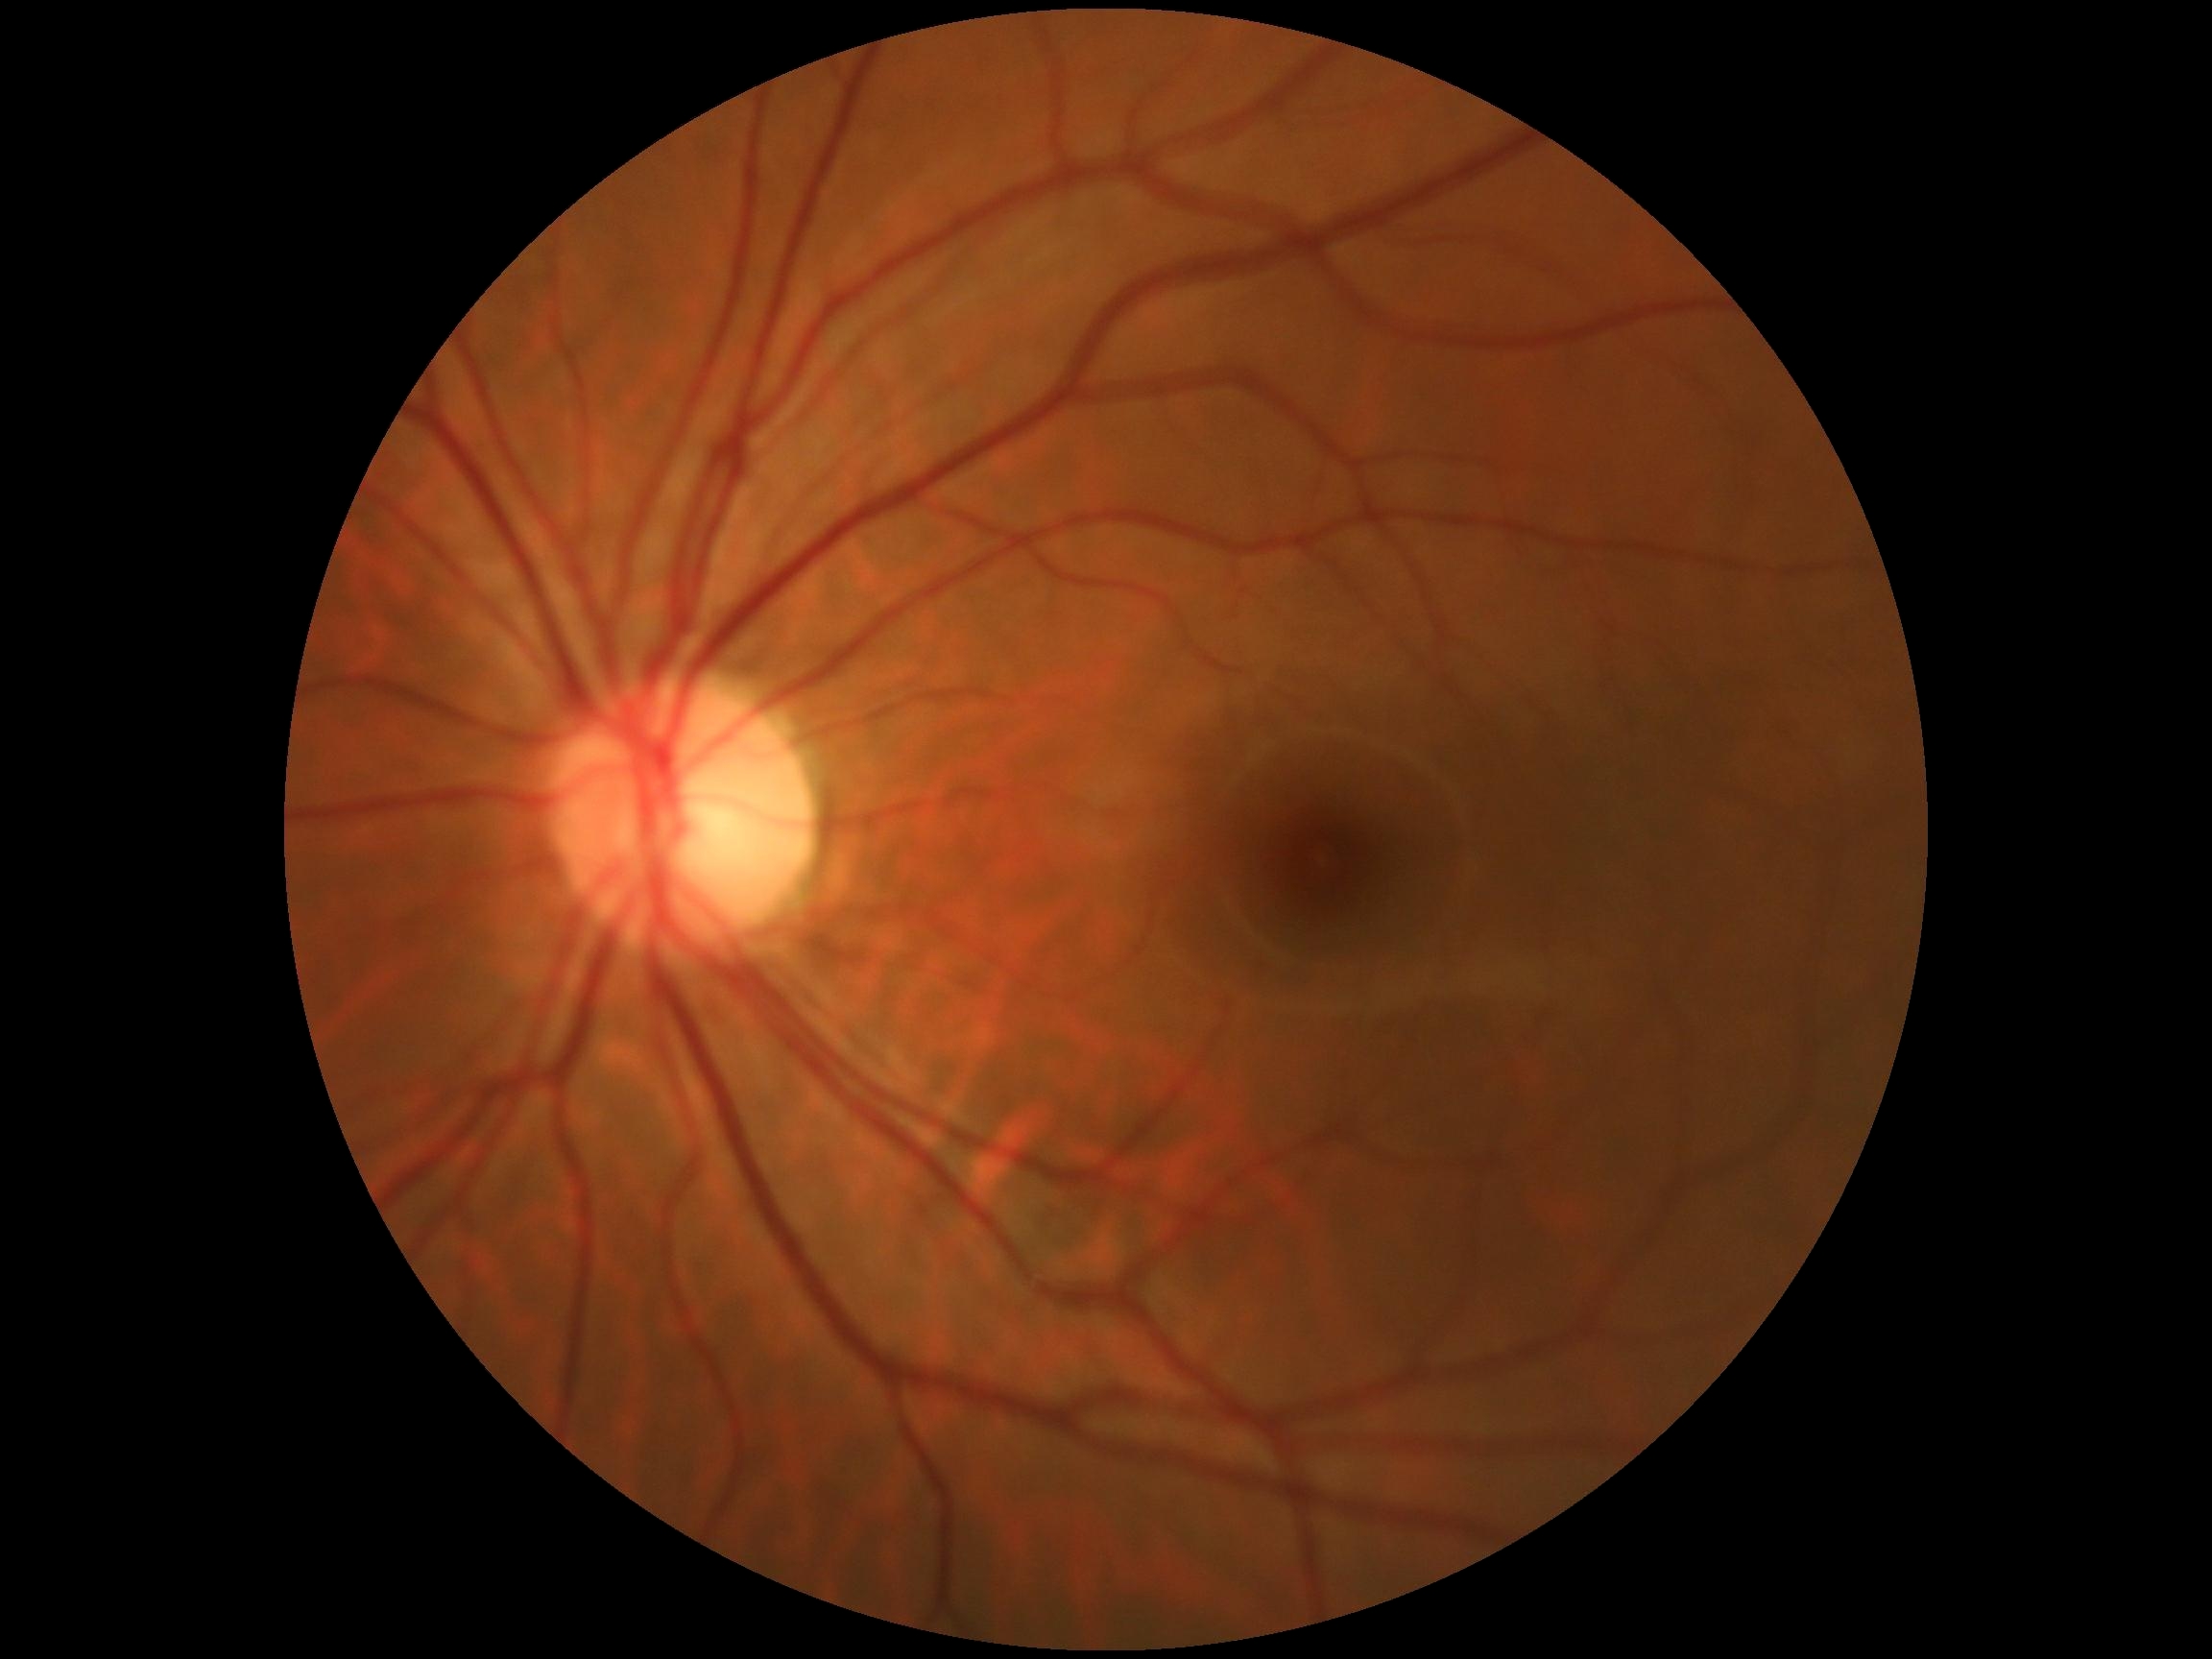
DR: grade 0.